Image size 532x532, fundus image cropped to the optic disc
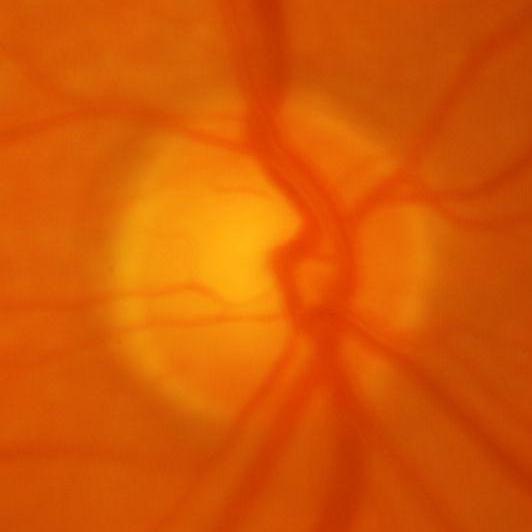 Glaucoma diagnosis: glaucomatous optic neuropathy.